Modified Davis grading; 45-degree field of view; acquired with a NIDEK AFC-230; 848x848px; retinal fundus photograph.
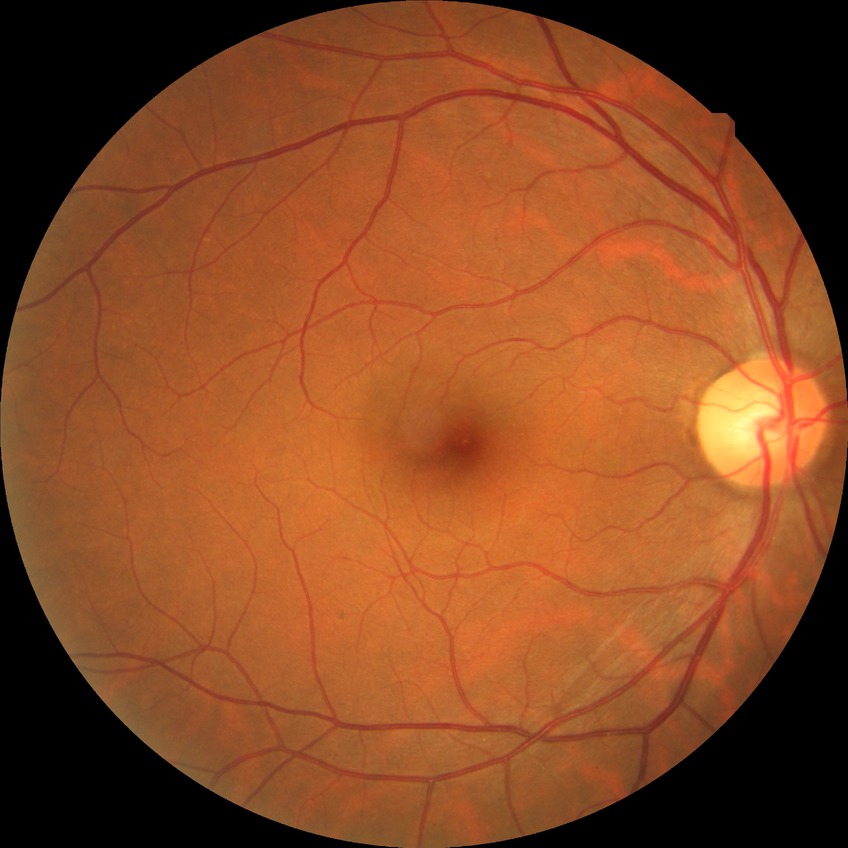

modified Davis grading: no diabetic retinopathy.